Nonmydriatic.
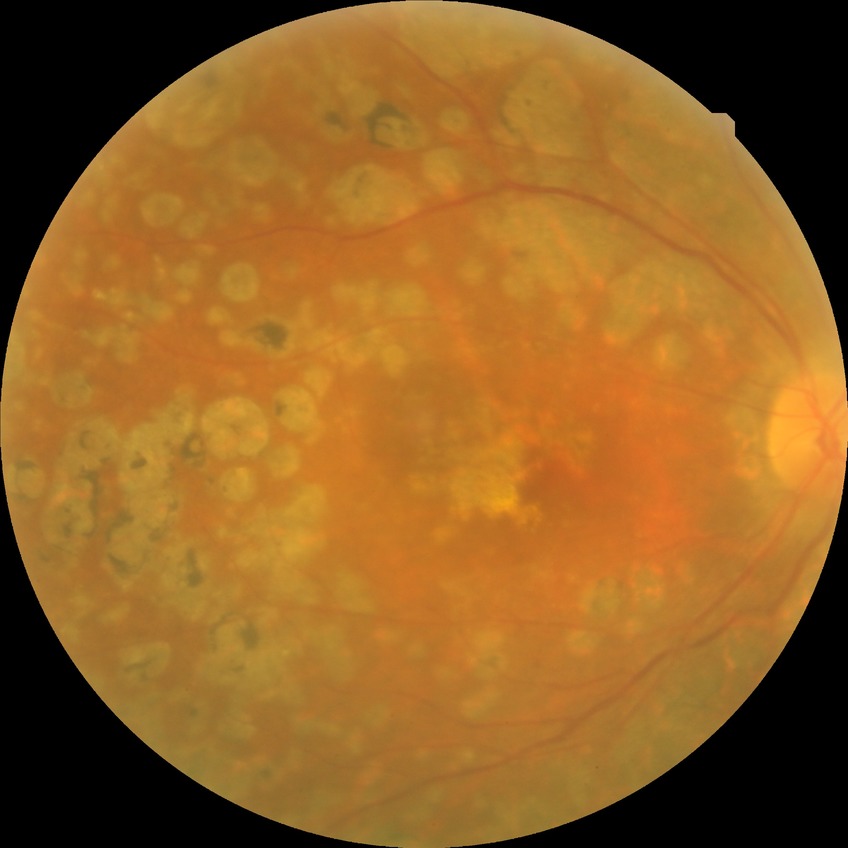
Annotations:
- diabetic retinopathy severity — proliferative diabetic retinopathy